Posterior pole color fundus photograph.
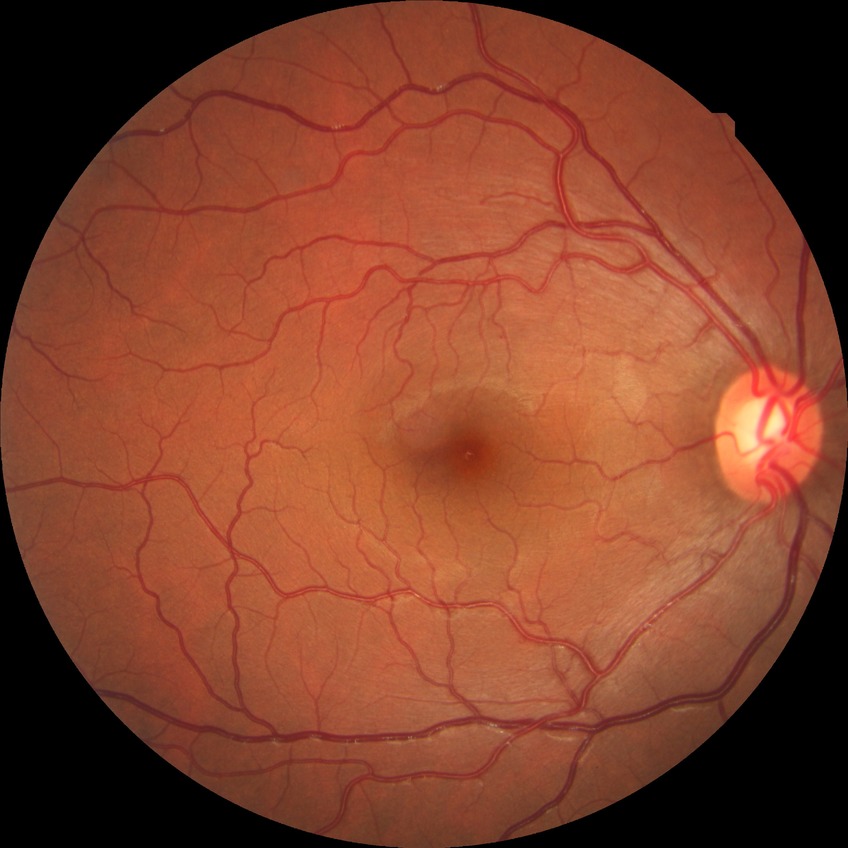 diabetic retinopathy (DR) = NDR (no diabetic retinopathy).